2184x1690; color fundus photograph.
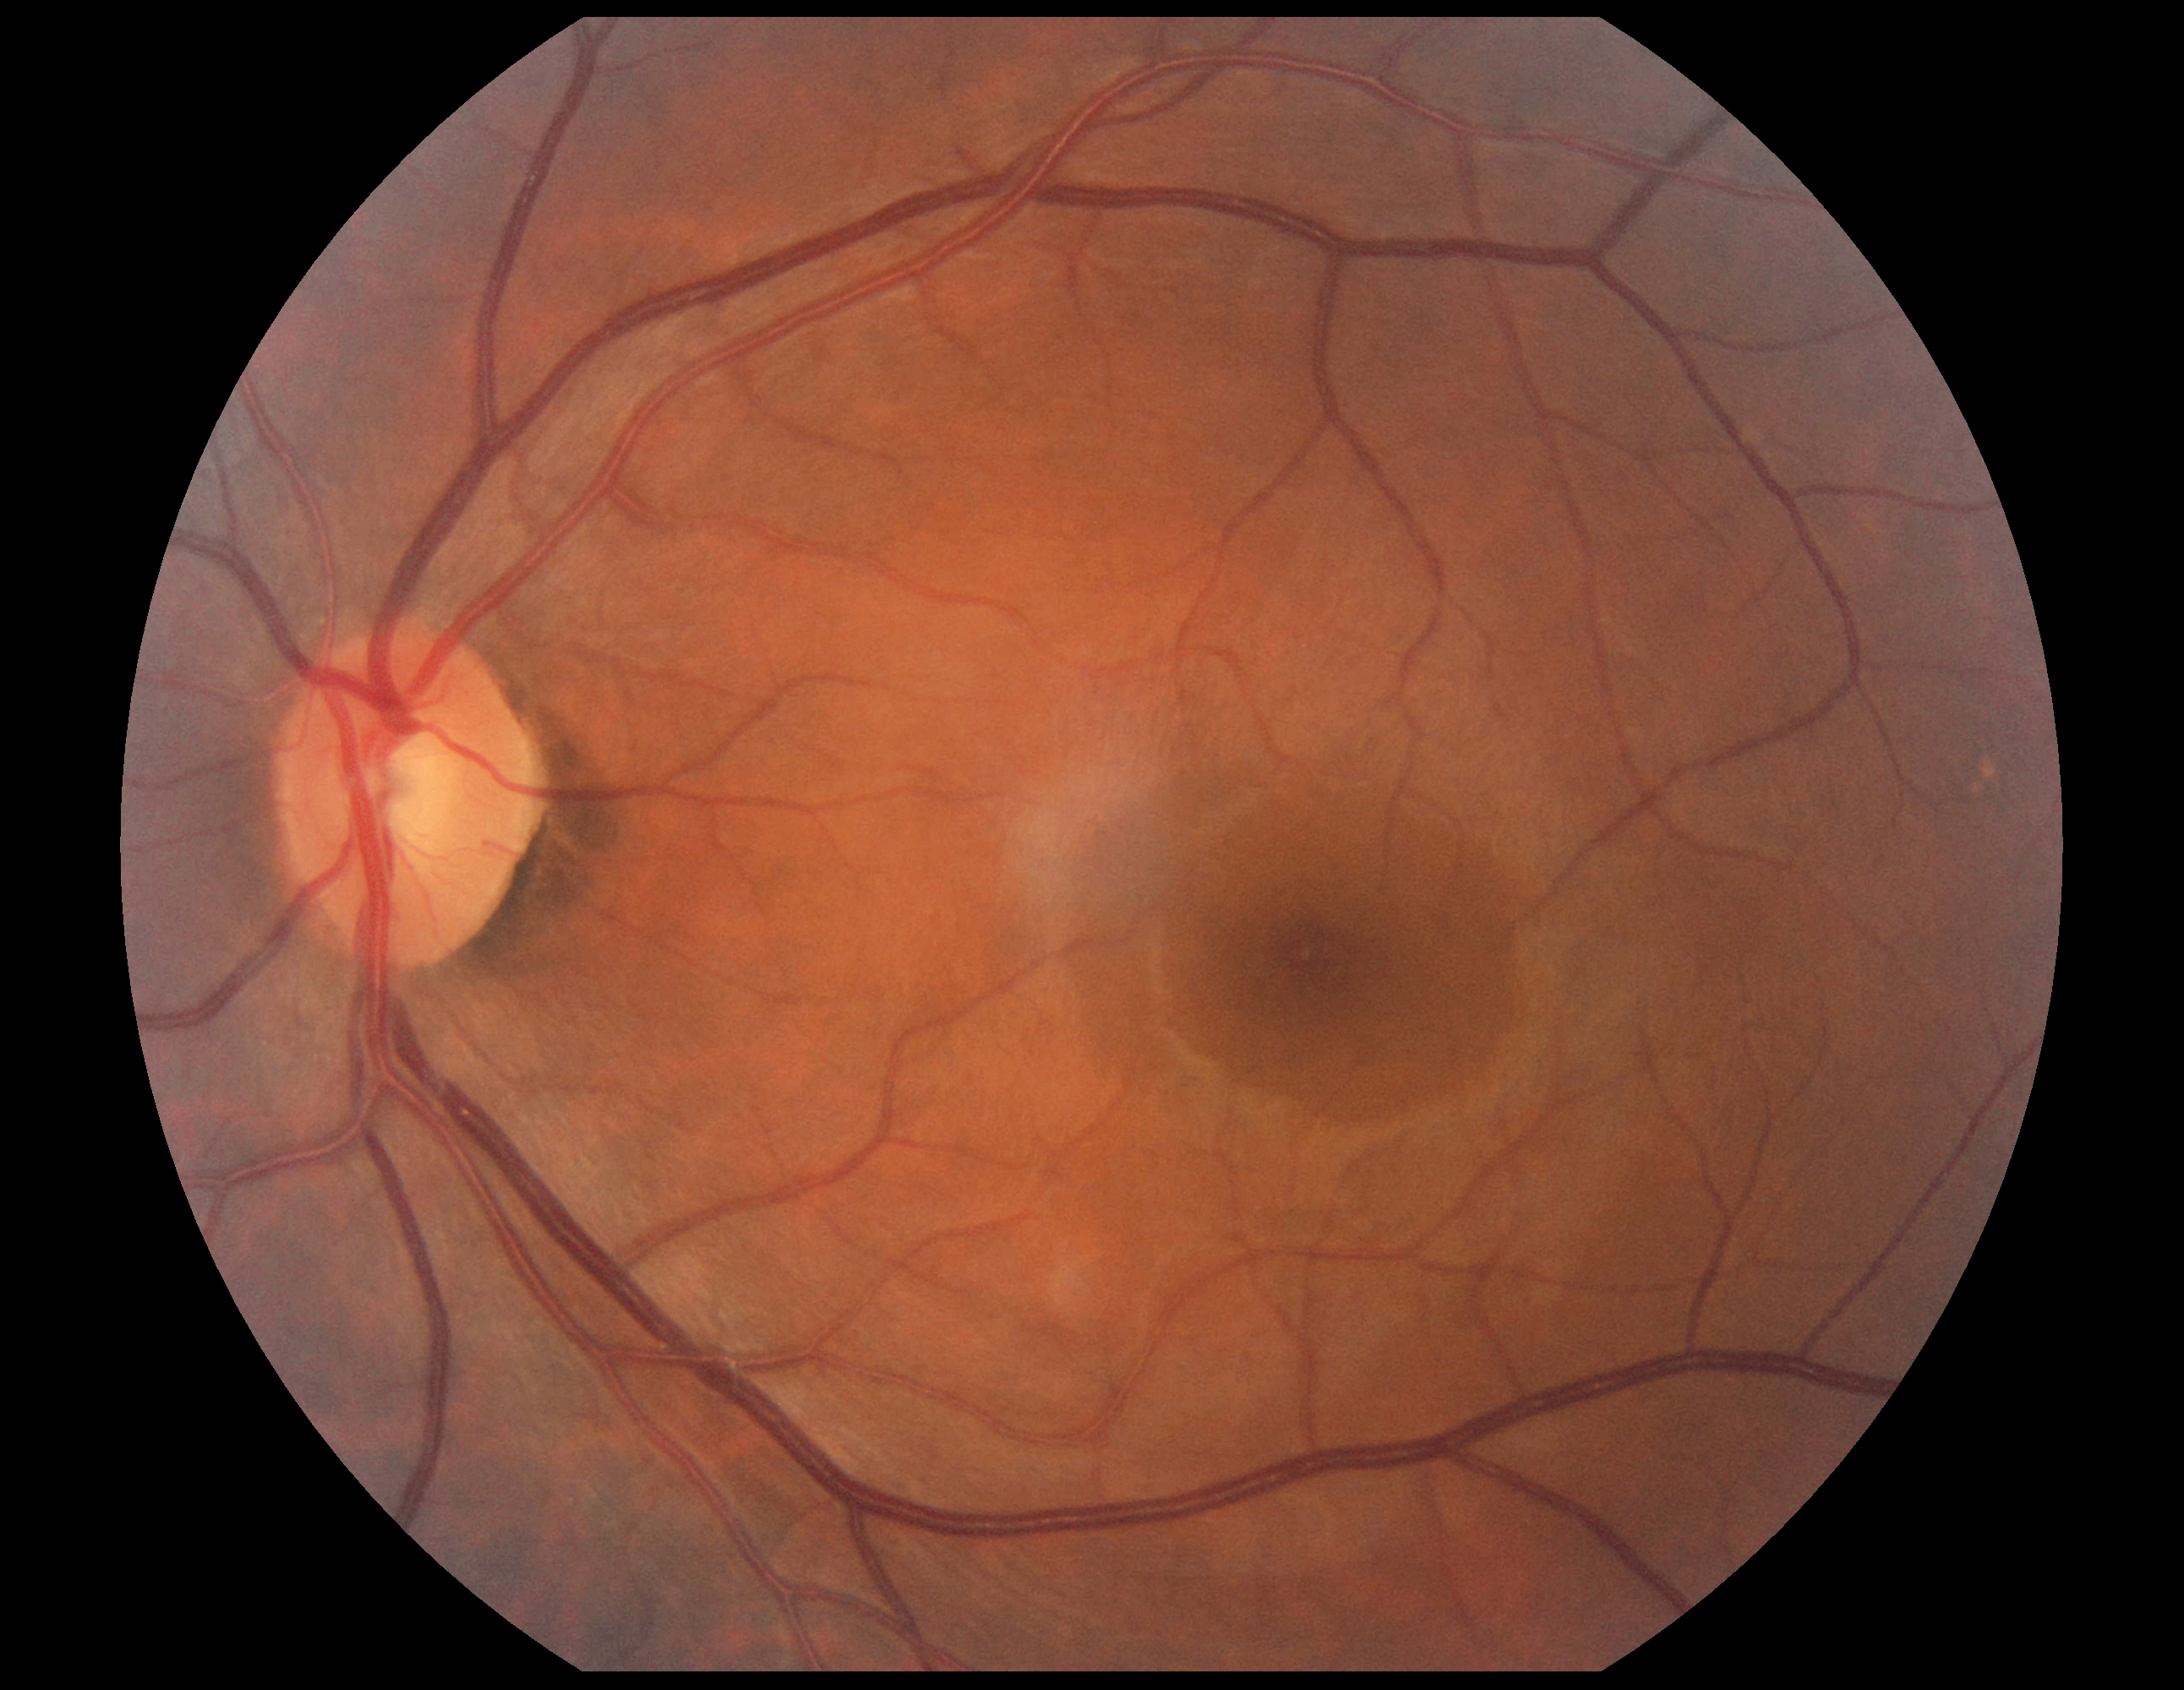 Diabetic retinopathy (DR) is grade 0 — no visible signs of diabetic retinopathy.